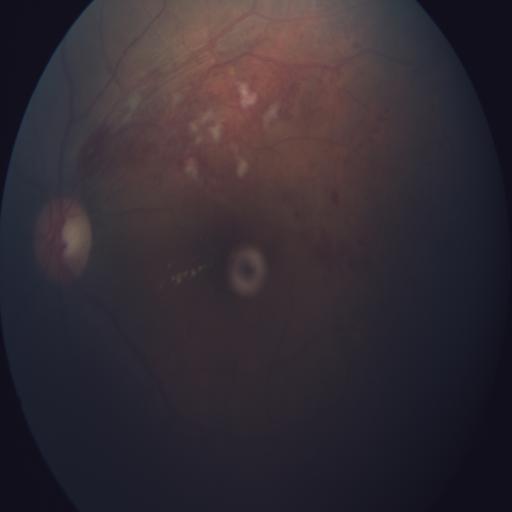 Diagnosis: branch retinal vein occlusion.